Camera: Nidek AFC-330. CFP. Non-mydriatic fundus camera:
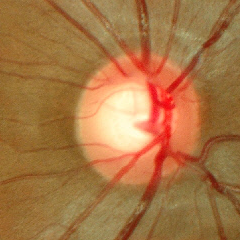

Glaucoma assessment: no glaucoma.